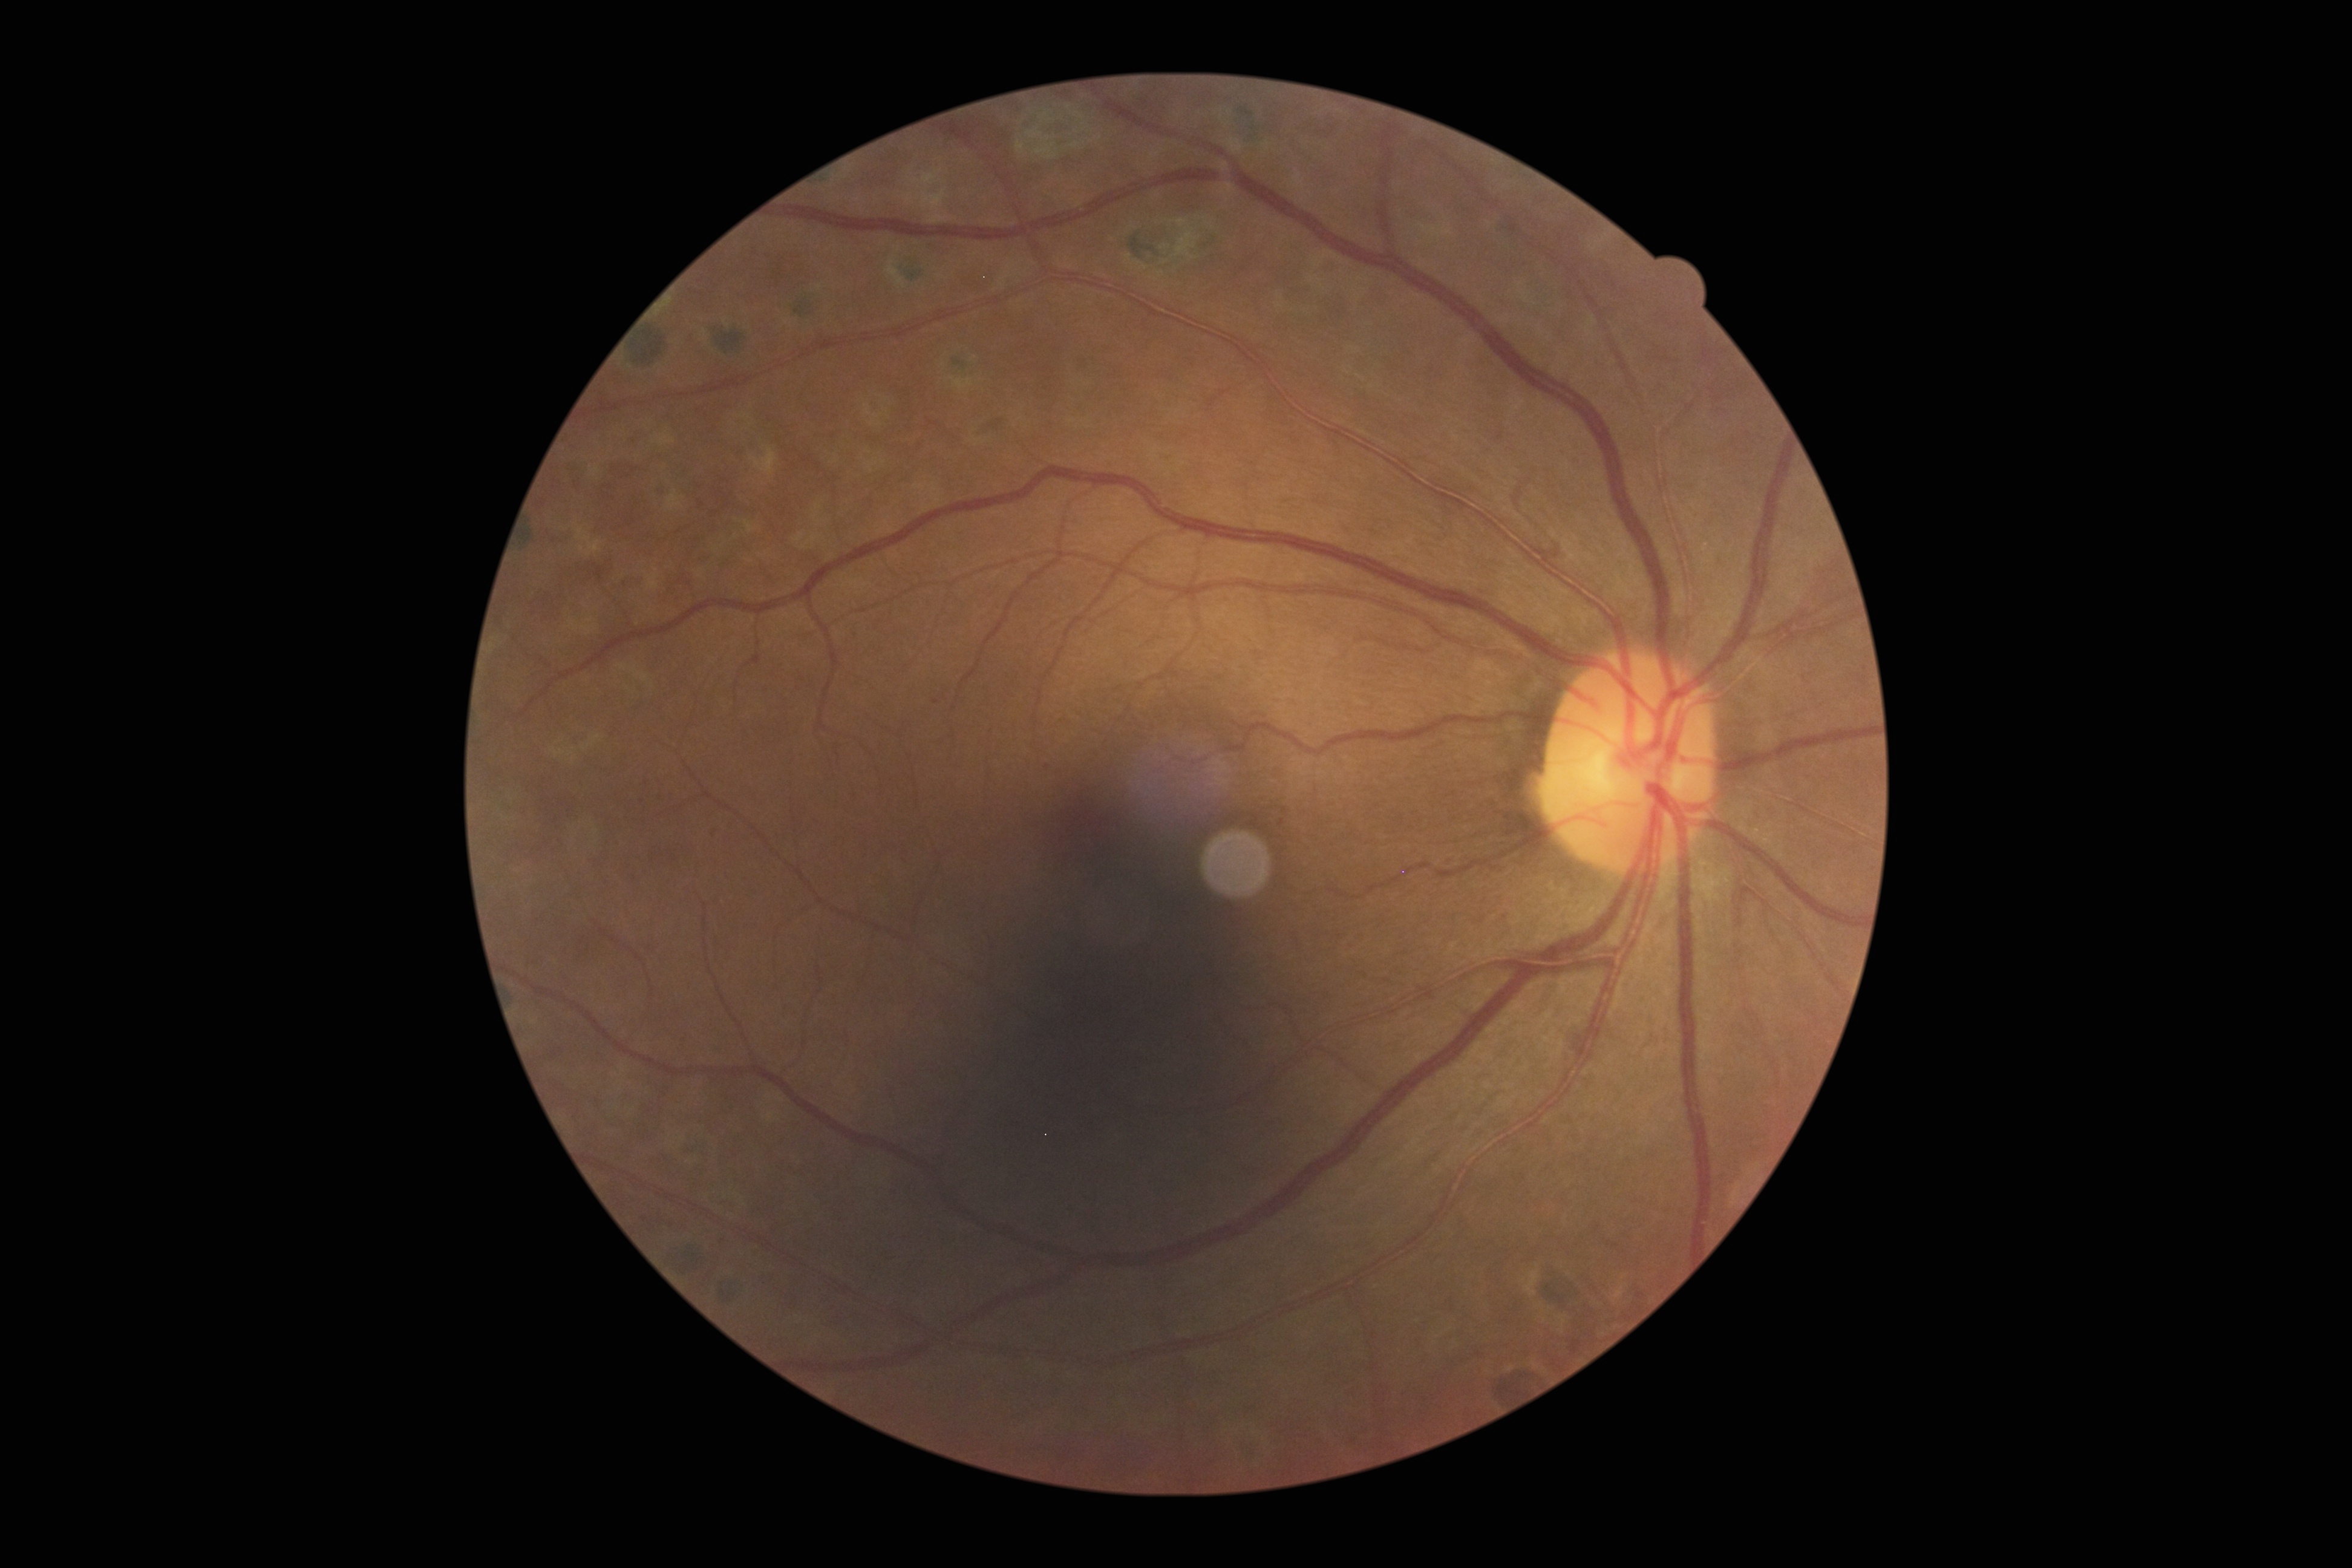

• DR class — non-proliferative diabetic retinopathy
• retinopathy — grade 1